CFP.
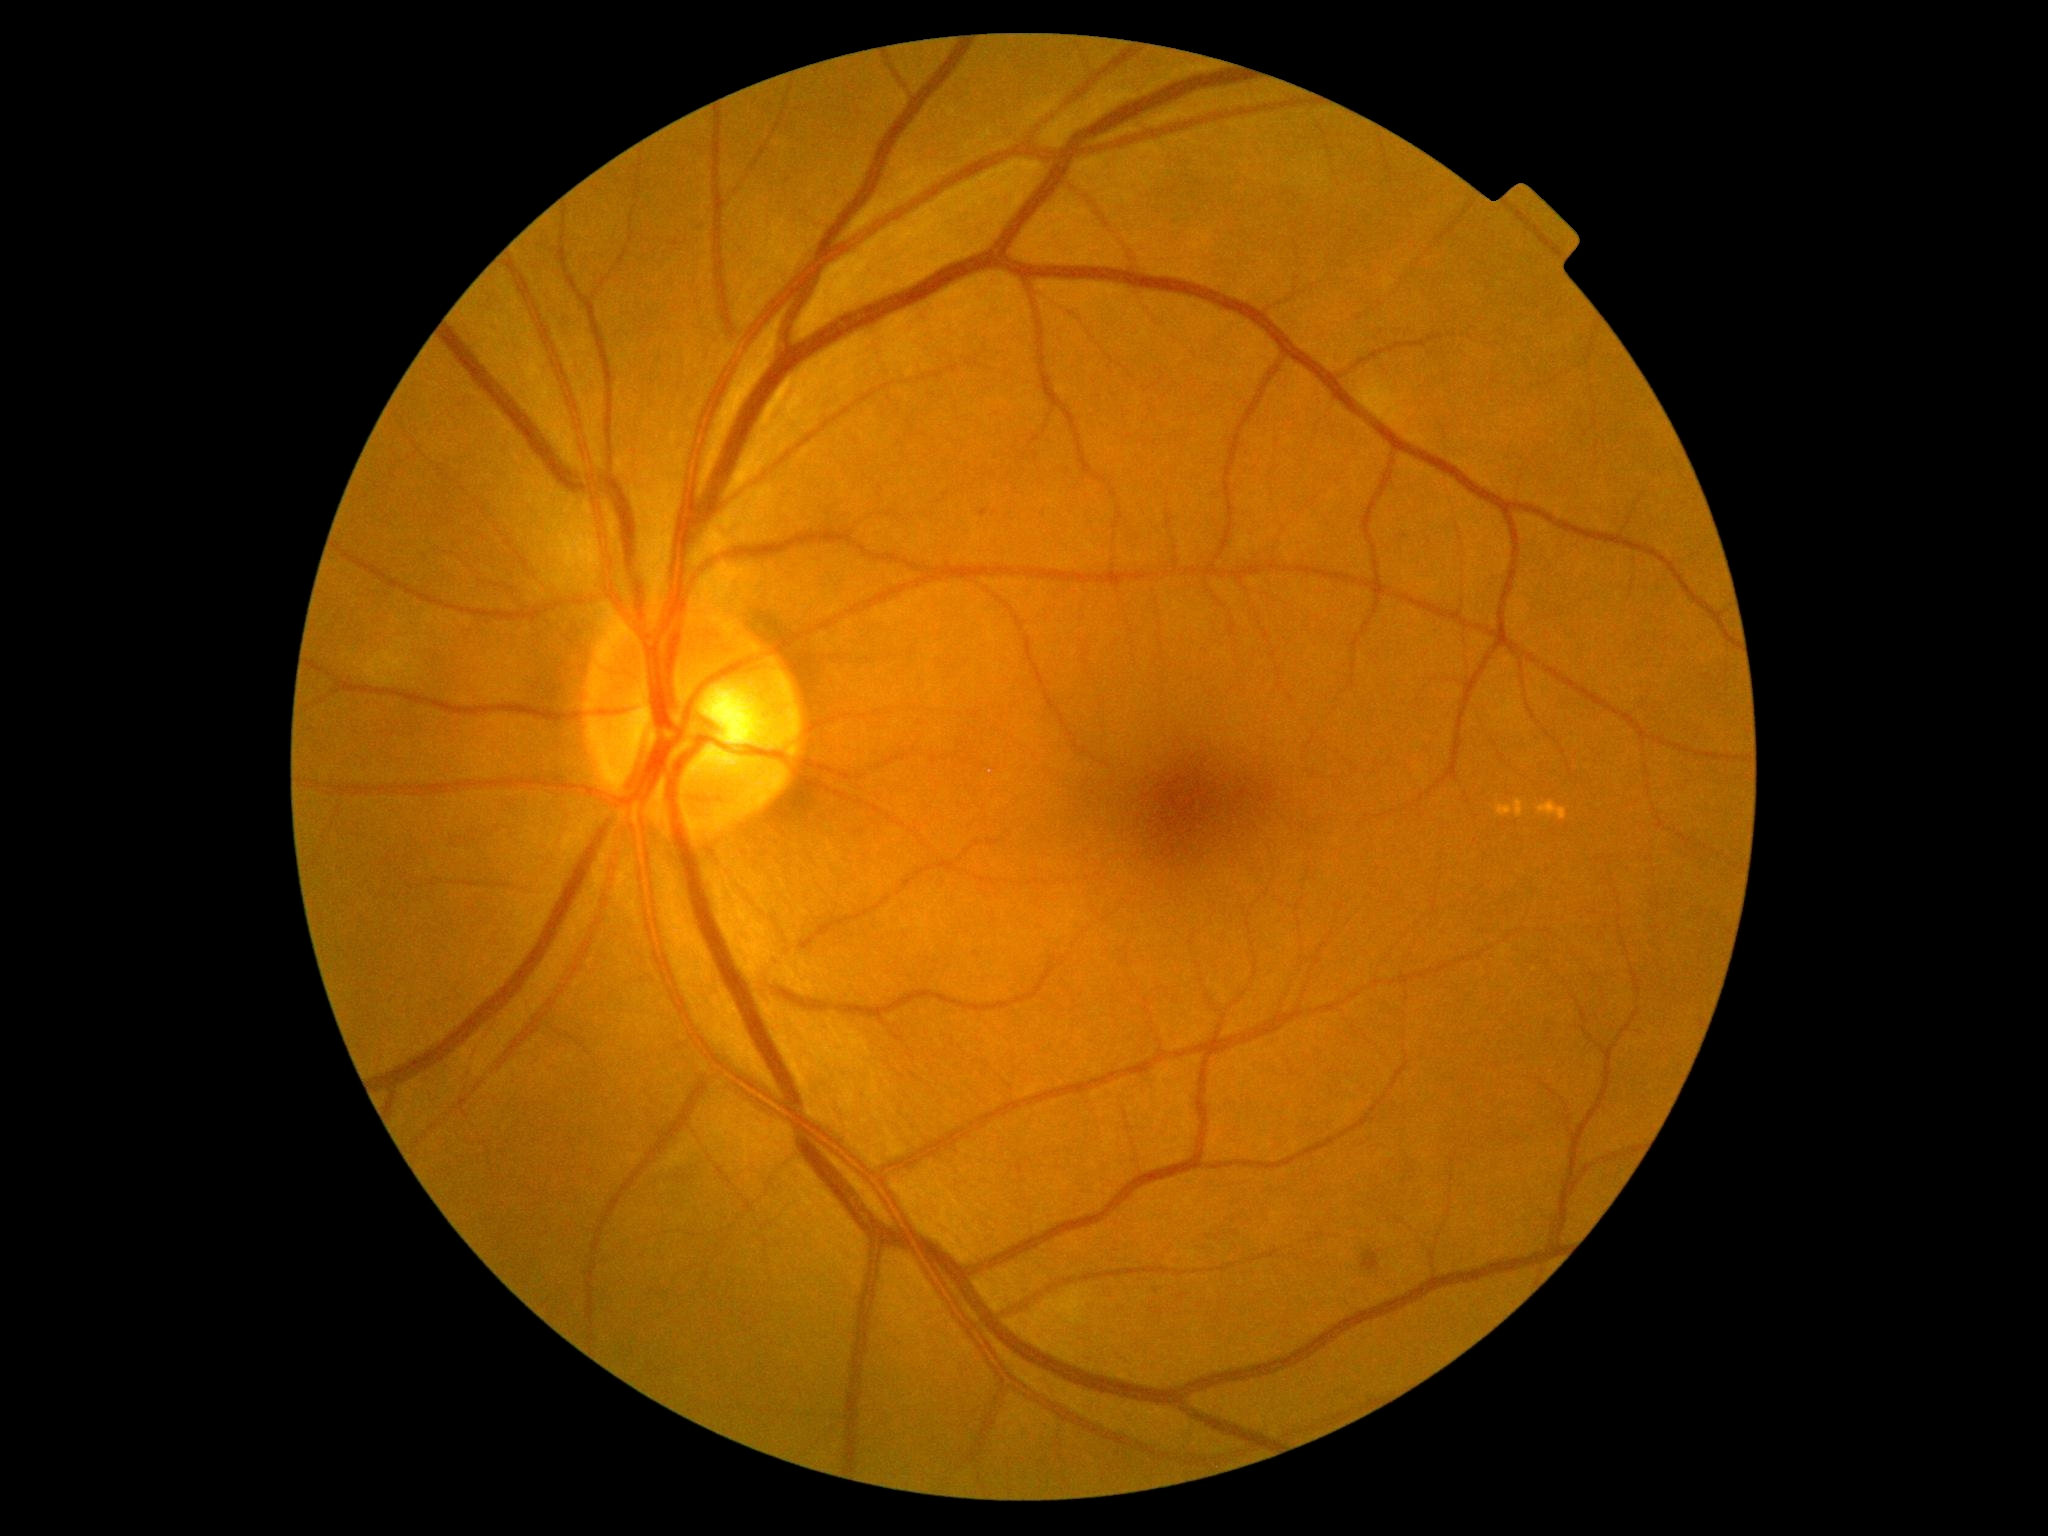

Diabetic retinopathy (DR): moderate NPDR (grade 2)
Lesions:
- microaneurysms (MAs): 980/510/989/518
- Smaller MAs around pt(1406, 536)
- soft exudates (SEs): absent
- hemorrhages (HEs): 1361/1250/1381/1272
- hard exudates (EXs): 1514/799/1524/818 | 1537/802/1567/820 | 1497/805/1513/816